Infant wide-field fundus photograph: 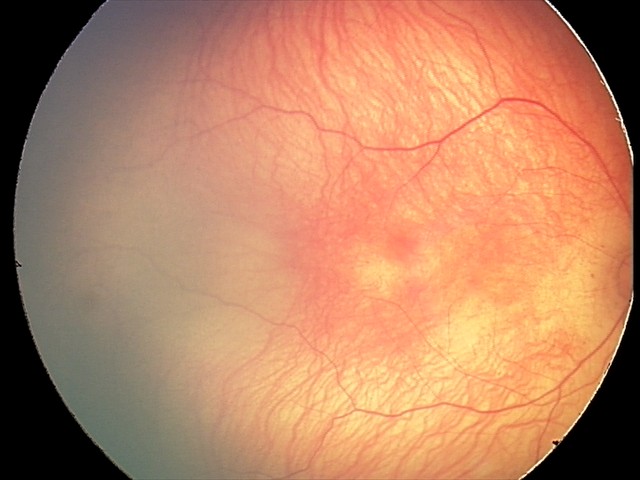

Screening: retinopathy of prematurity stage 1 | no plus disease.